1240x1240px · pediatric wide-field fundus photograph · Phoenix ICON, 100° FOV.
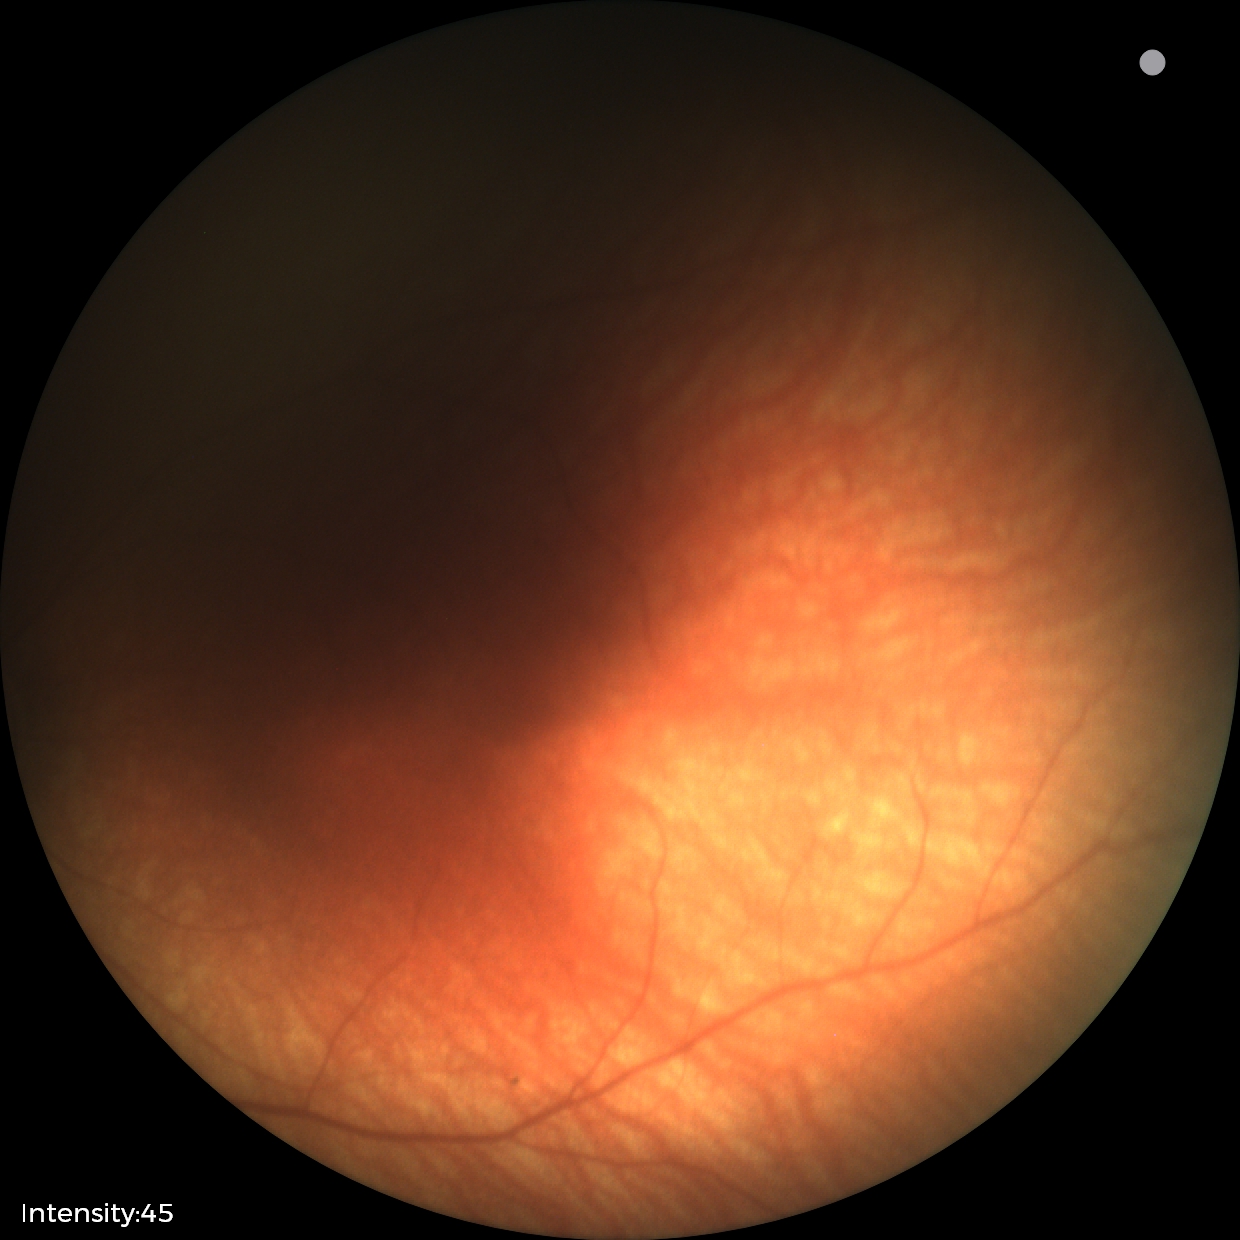
Physiological retinal appearance for postconceptual age.